Graded on the modified Davis scale: 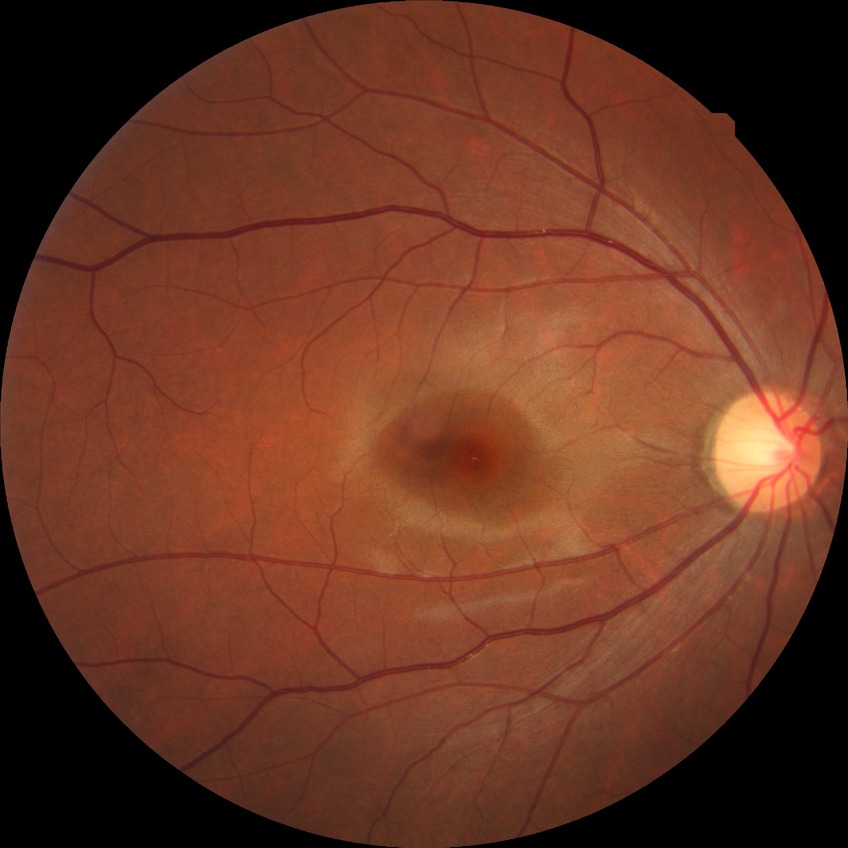

DR impression: no signs of DR
Davis DR grade: NDR